Field includes the optic disc and macula:
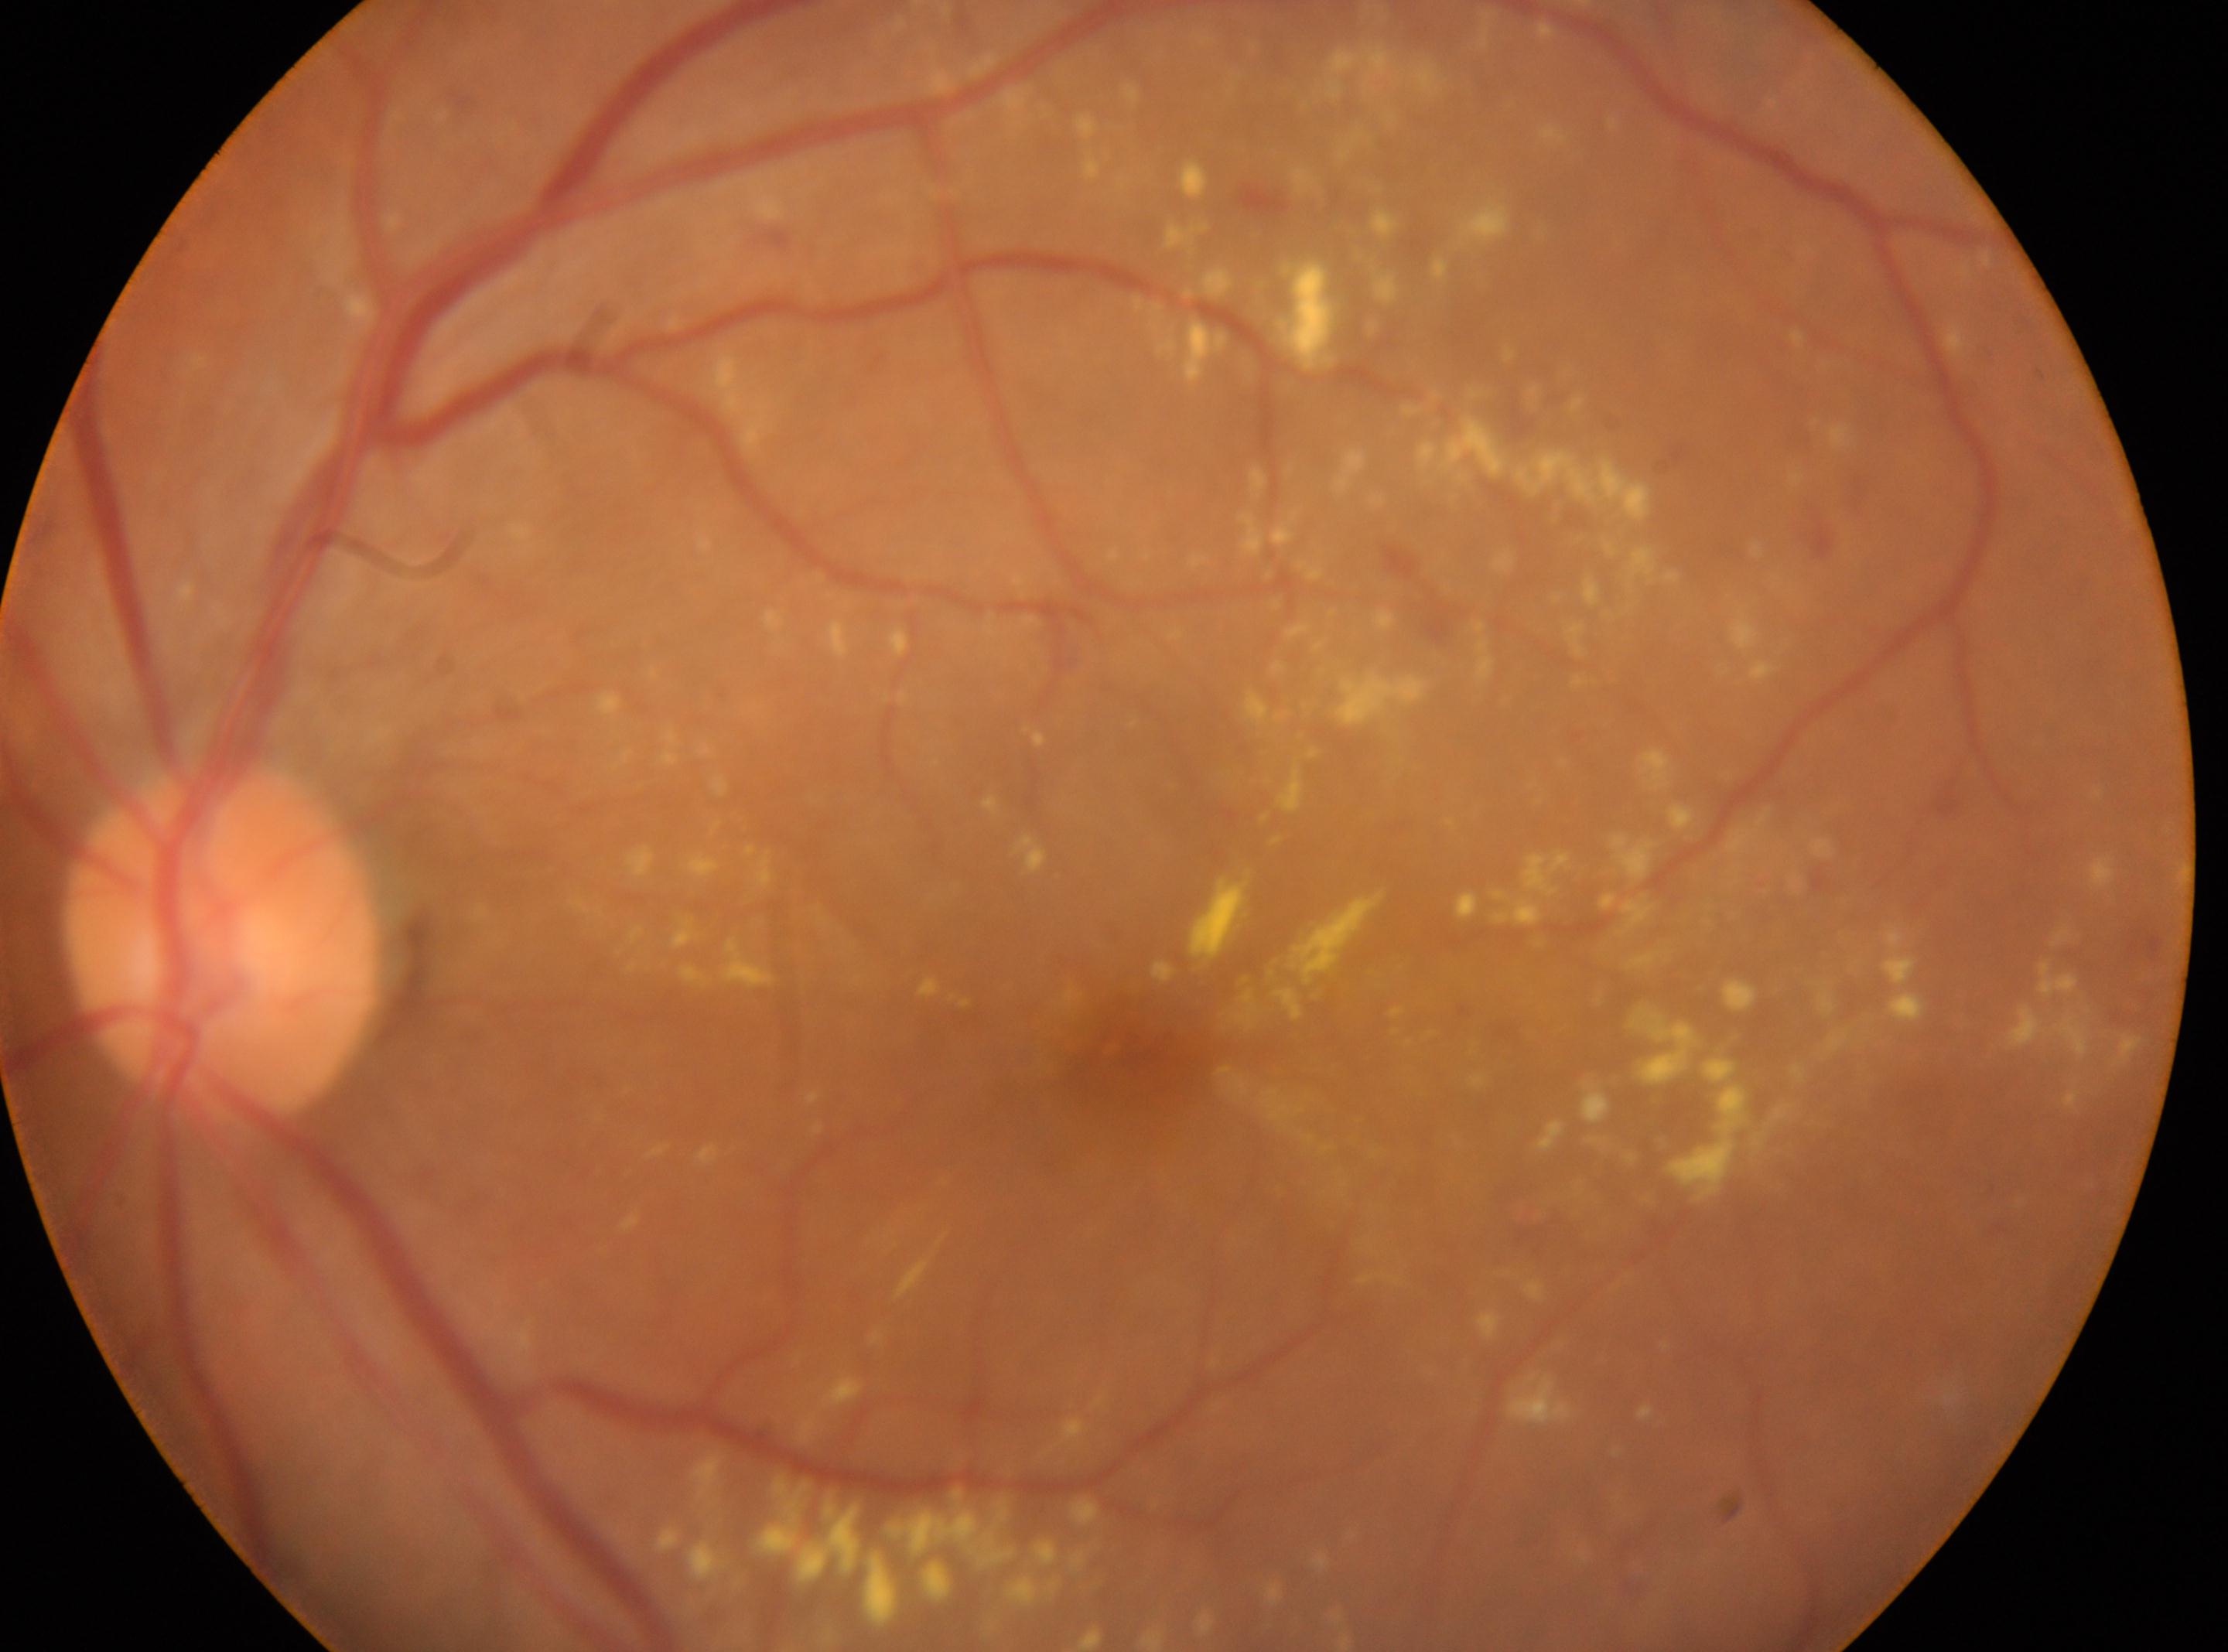

optic disk: 223, 940
DR class: non-proliferative diabetic retinopathy
the fovea: 1139, 1055
laterality: the left eye
DR grade: moderate NPDR (2) — more than just microaneurysms but less than severe NPDR